Acquired with a NIDEK AFC-230; FOV: 45 degrees
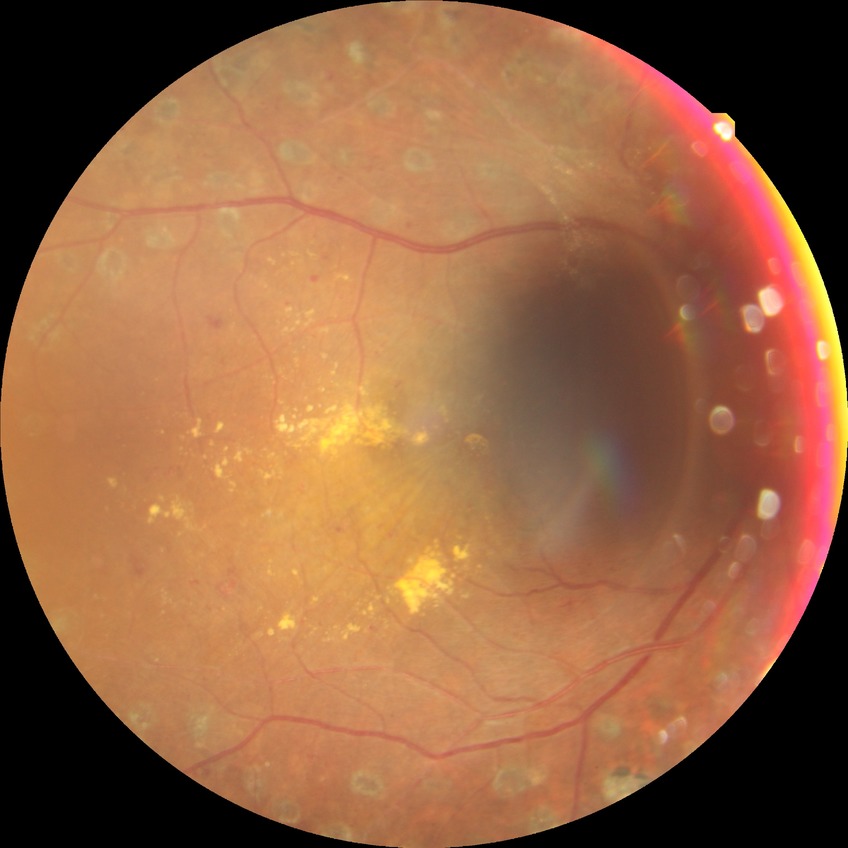 Diabetic retinopathy (DR): proliferative diabetic retinopathy (PDR).